Retinal fundus photograph: 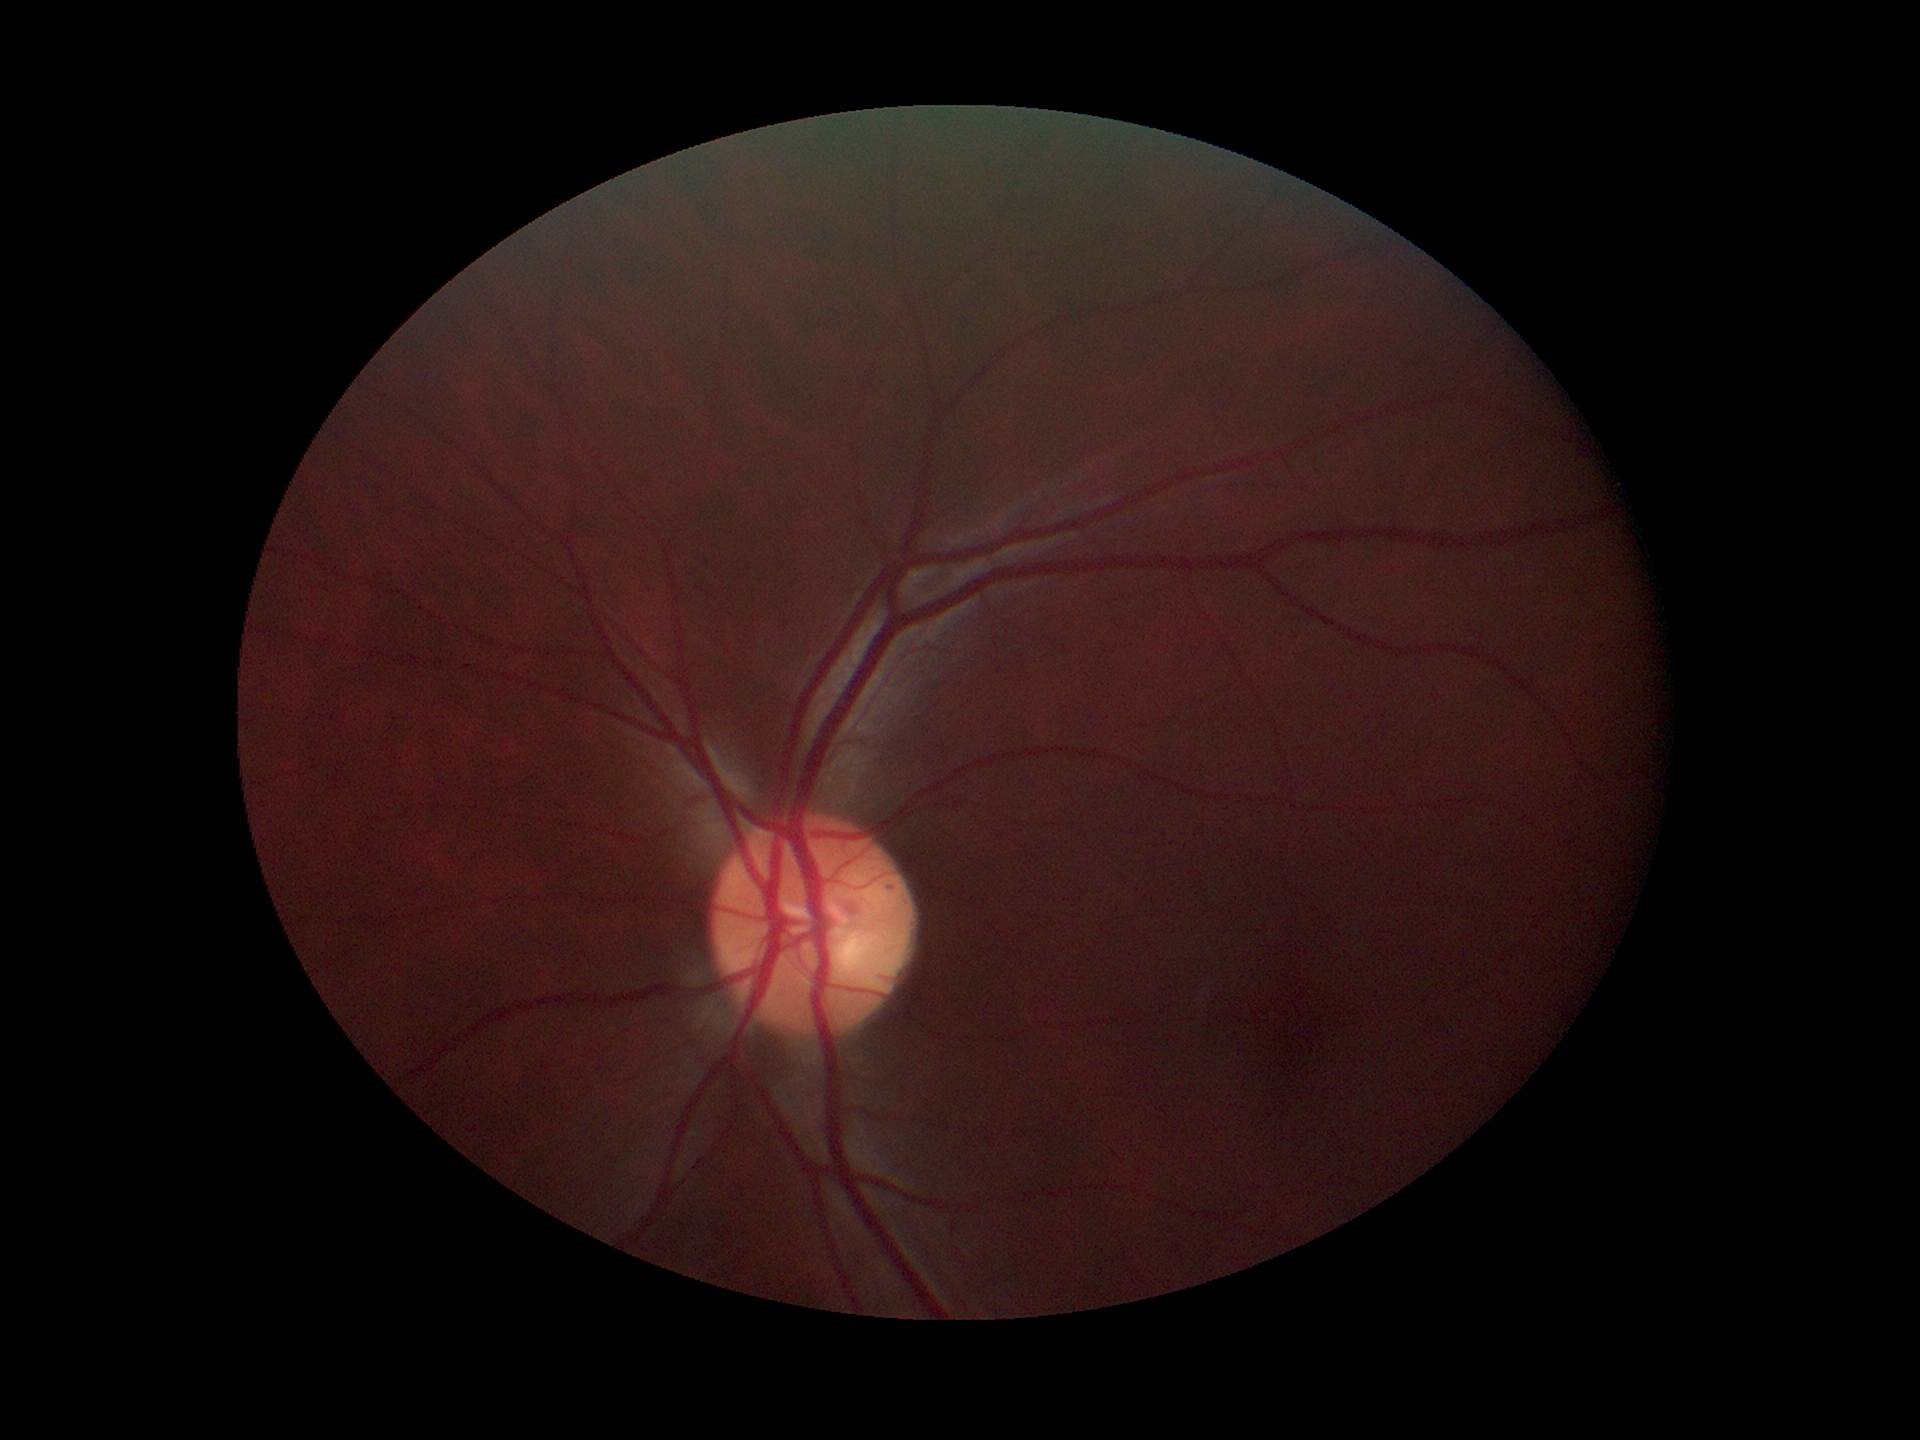

Glaucoma evaluation = not suspect; VCDR = 0.44.